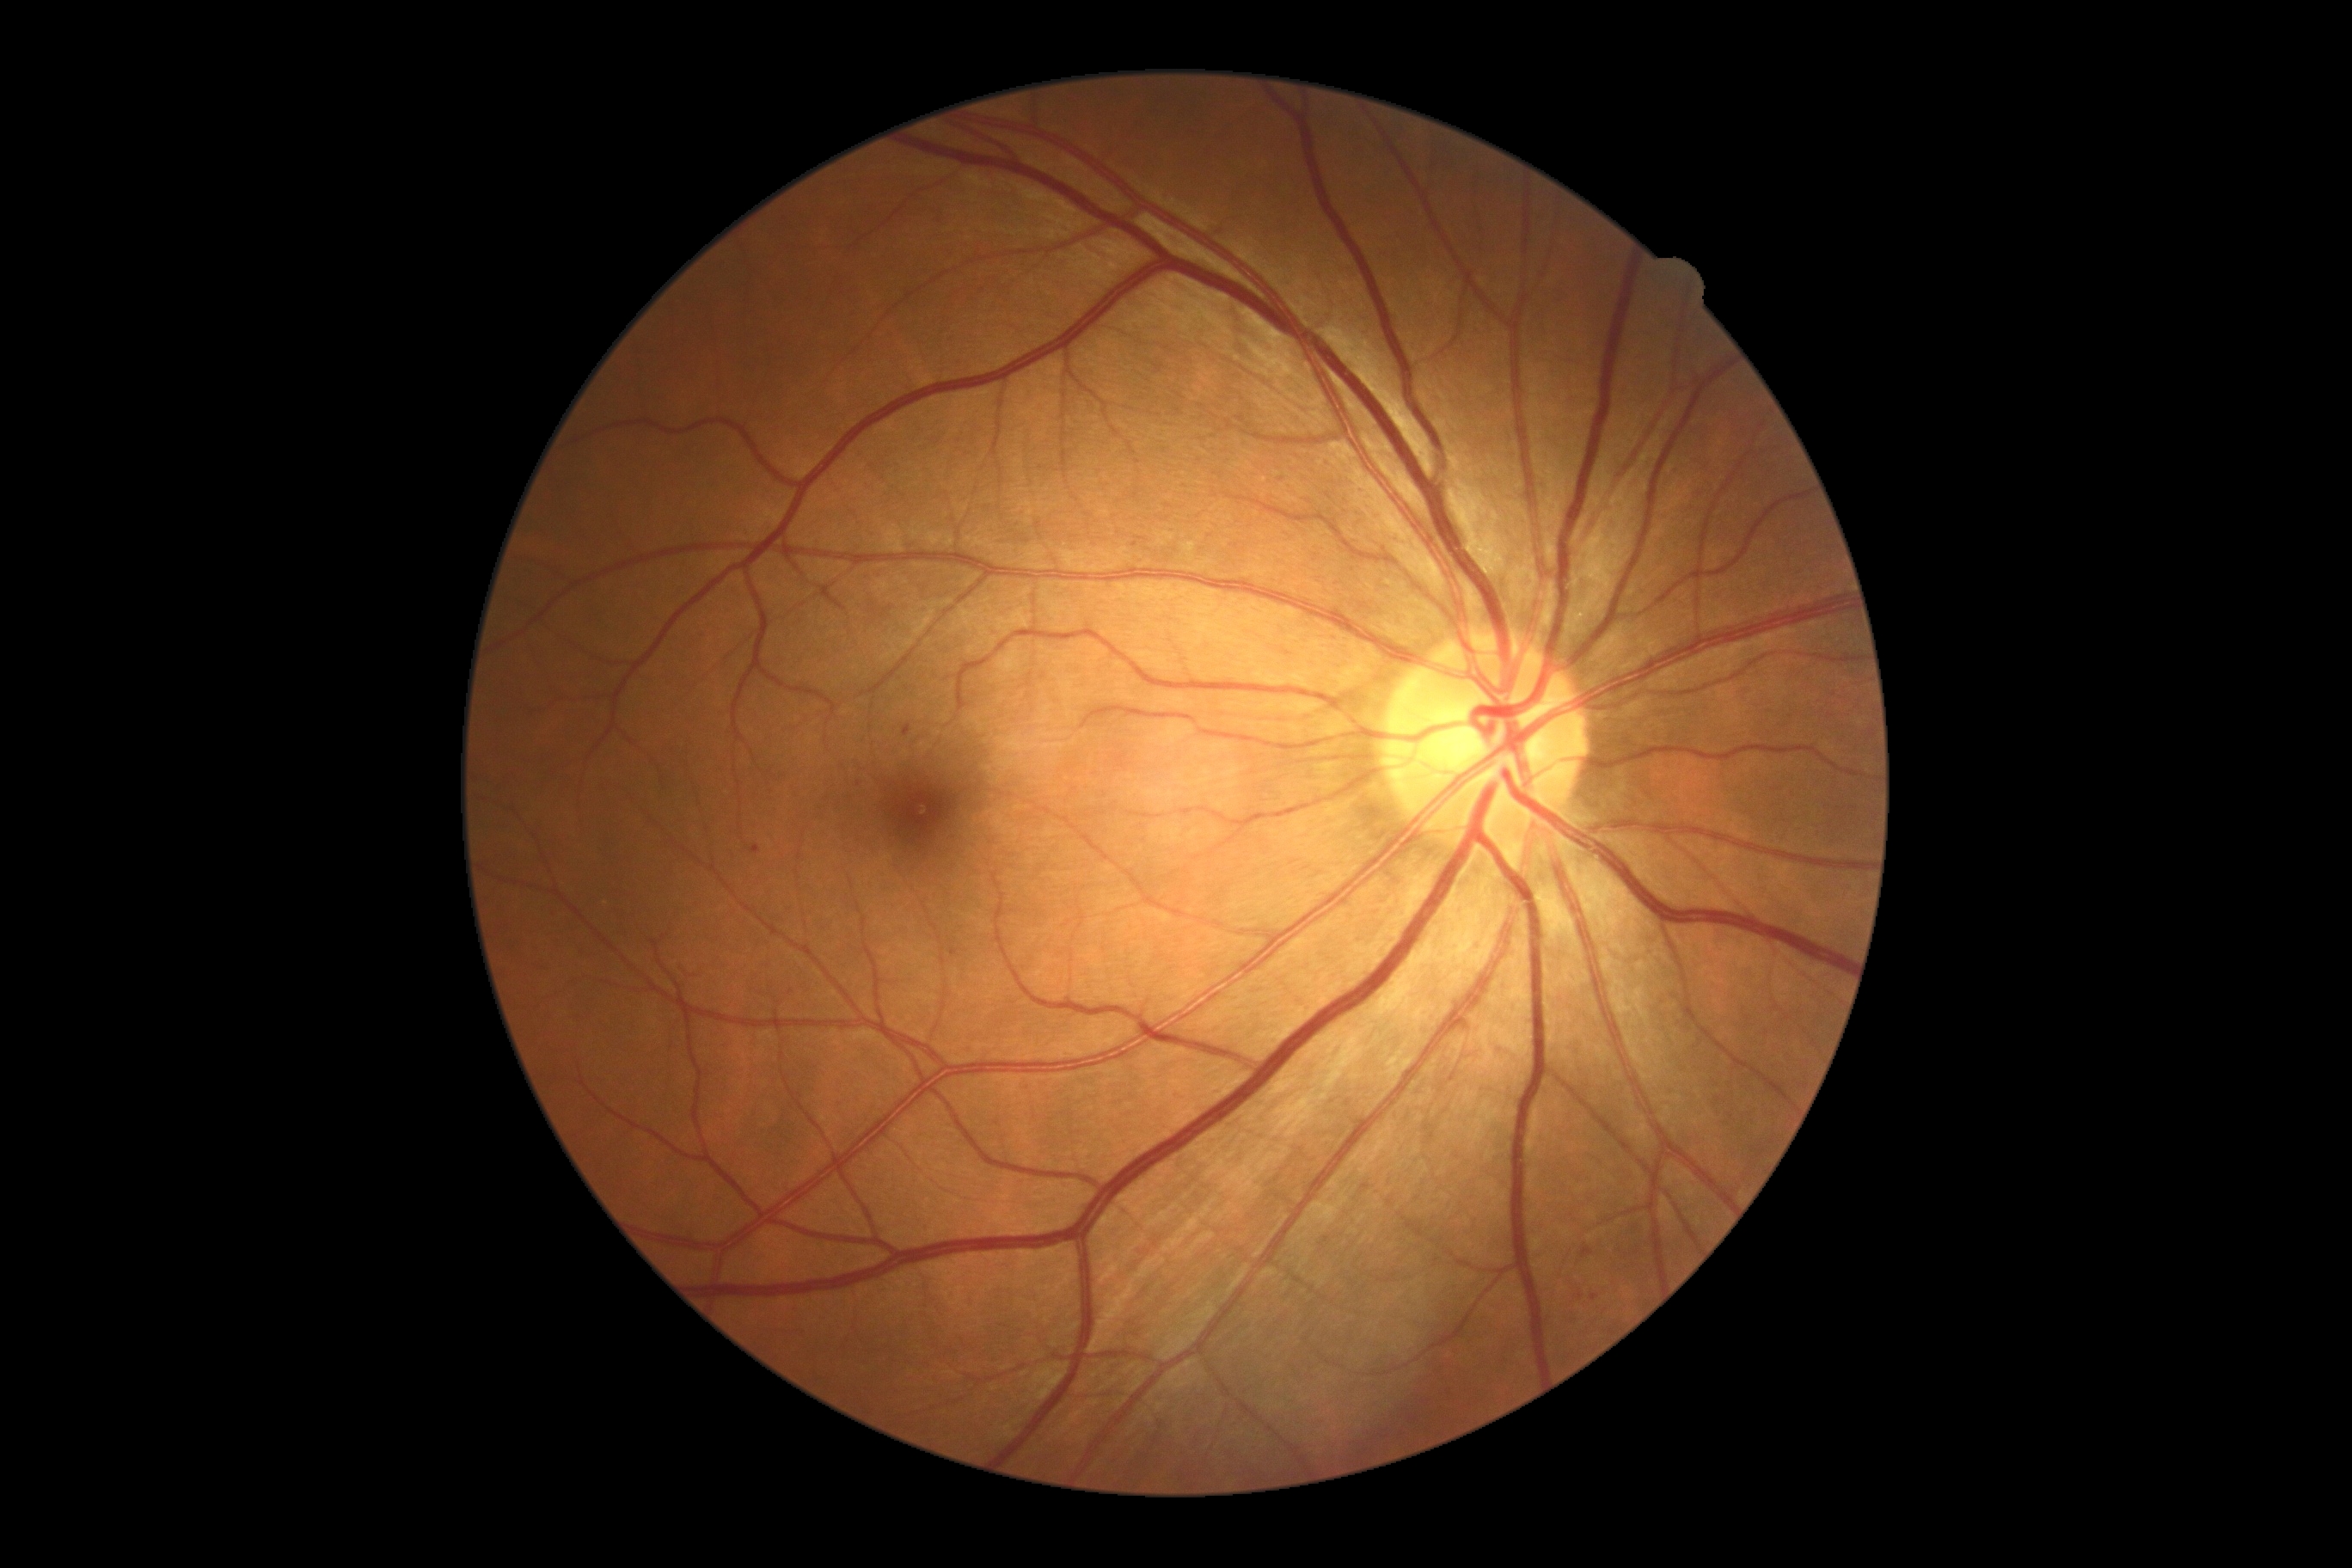

DR is mild non-proliferative diabetic retinopathy (grade 1)
HEs = Rect(750, 845, 761, 855); Rect(1581, 1244, 1595, 1259); Rect(903, 725, 912, 738); Rect(950, 948, 959, 957); Rect(1577, 1290, 1584, 1301)
Additional small HEs near Point(859, 784); Point(1594, 1298)
SEs = not present
EXs = not present
MAs = not present